FOV: 45 degrees.
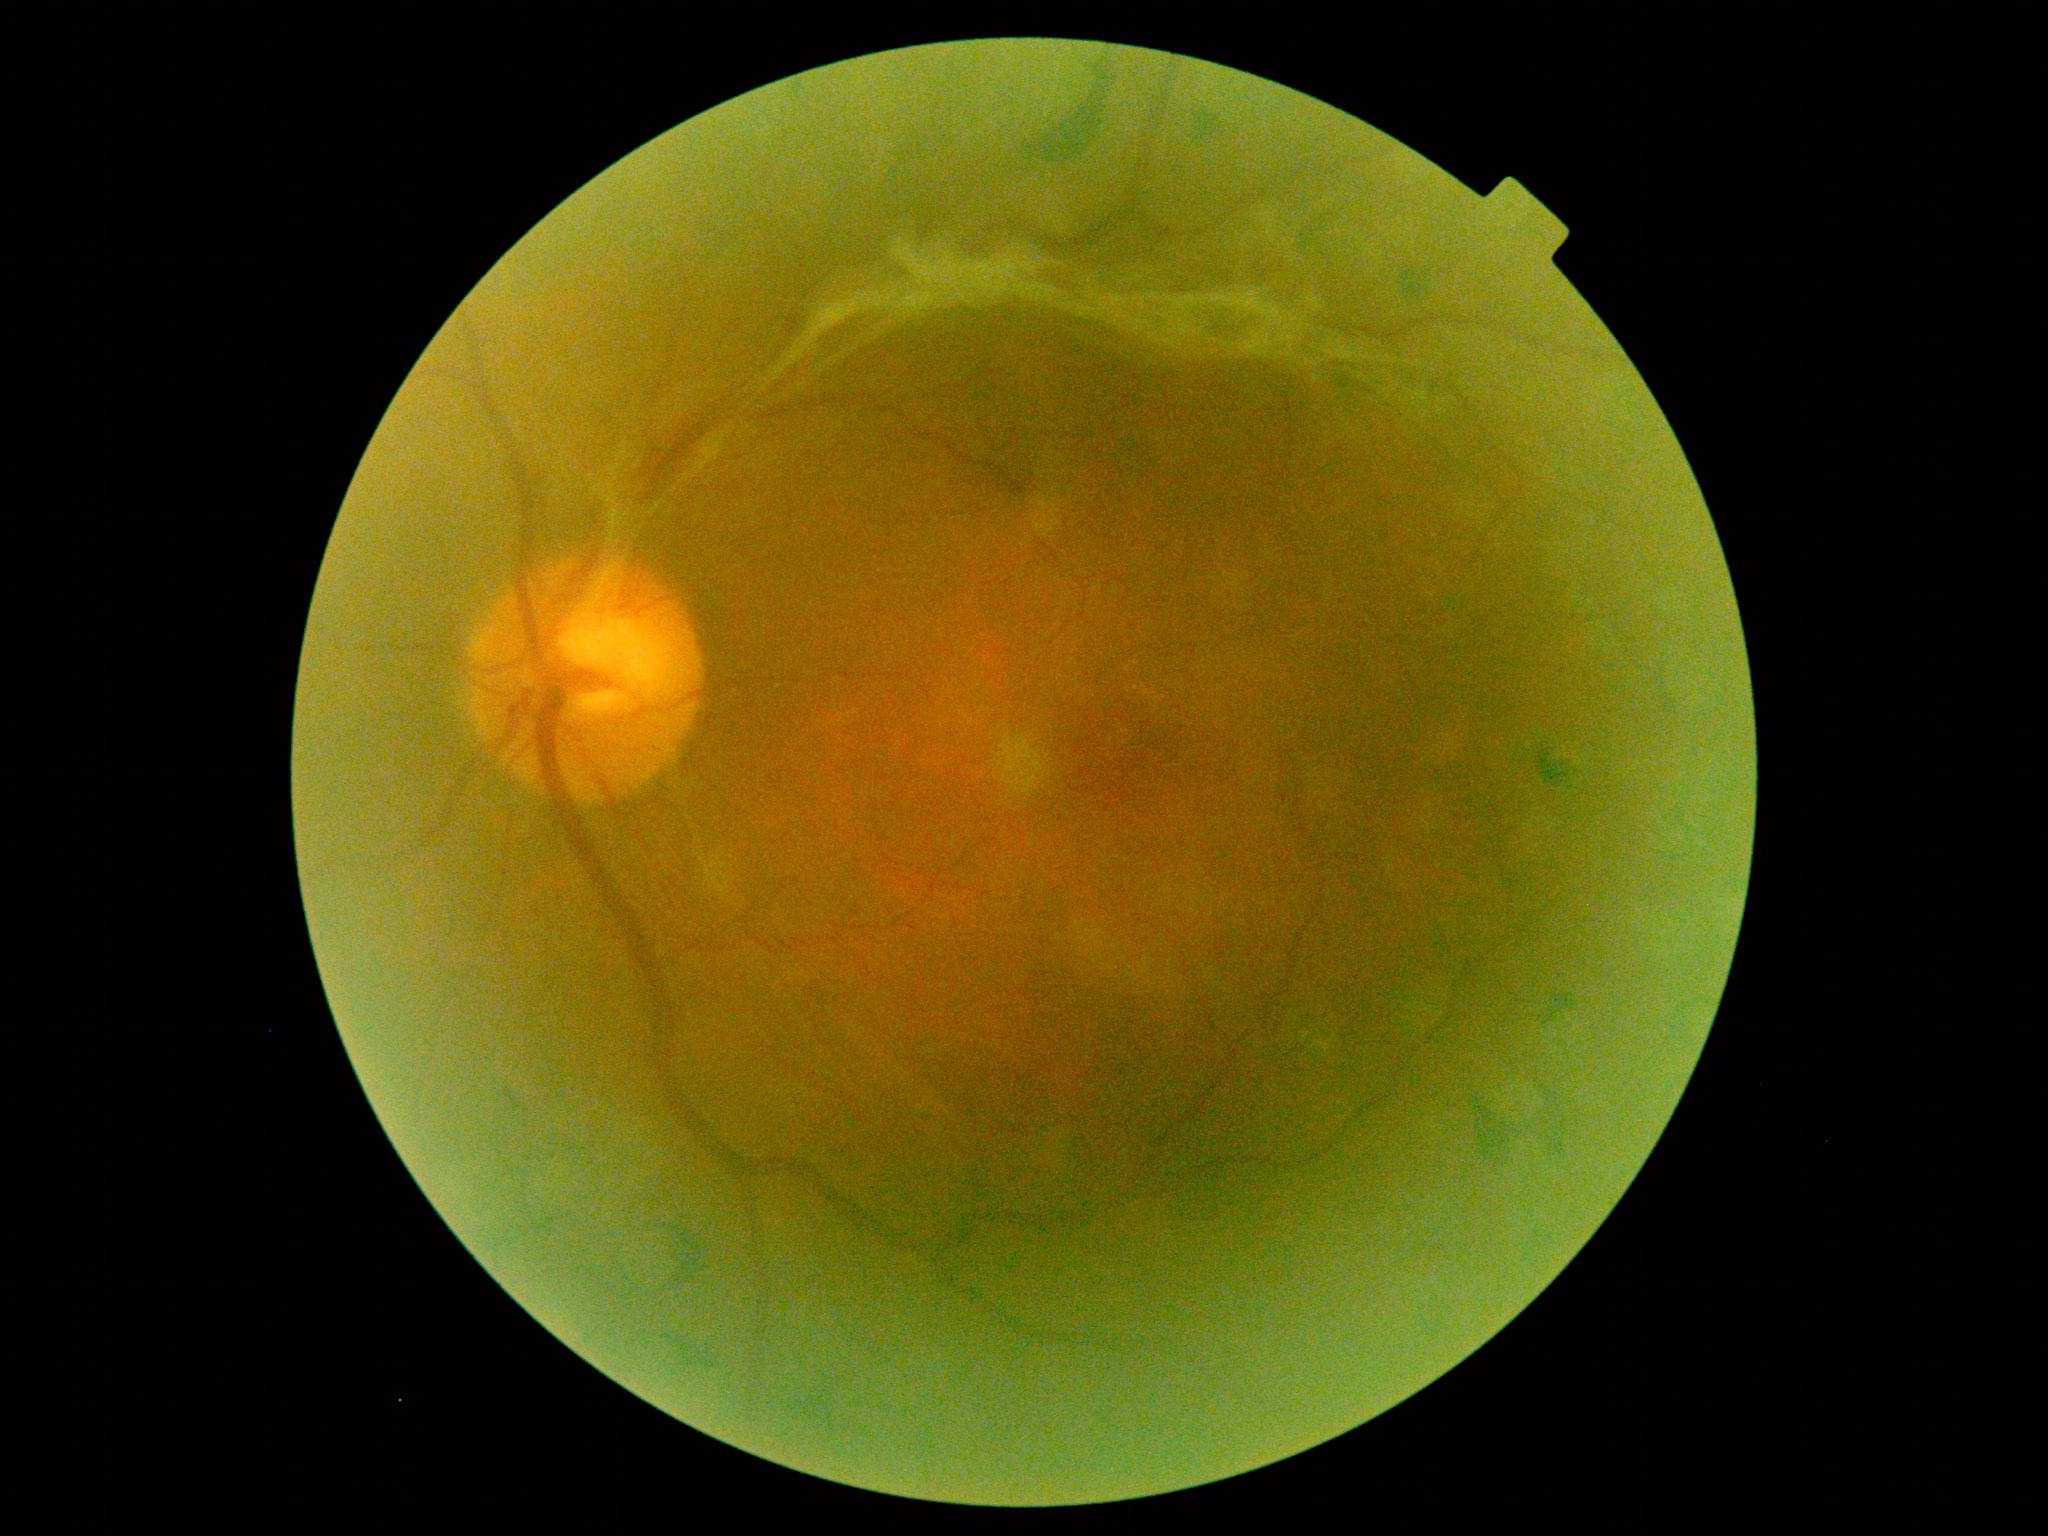

Diabetic retinopathy grade is 4/4.